2212 by 1659 pixels. Fundus photo:
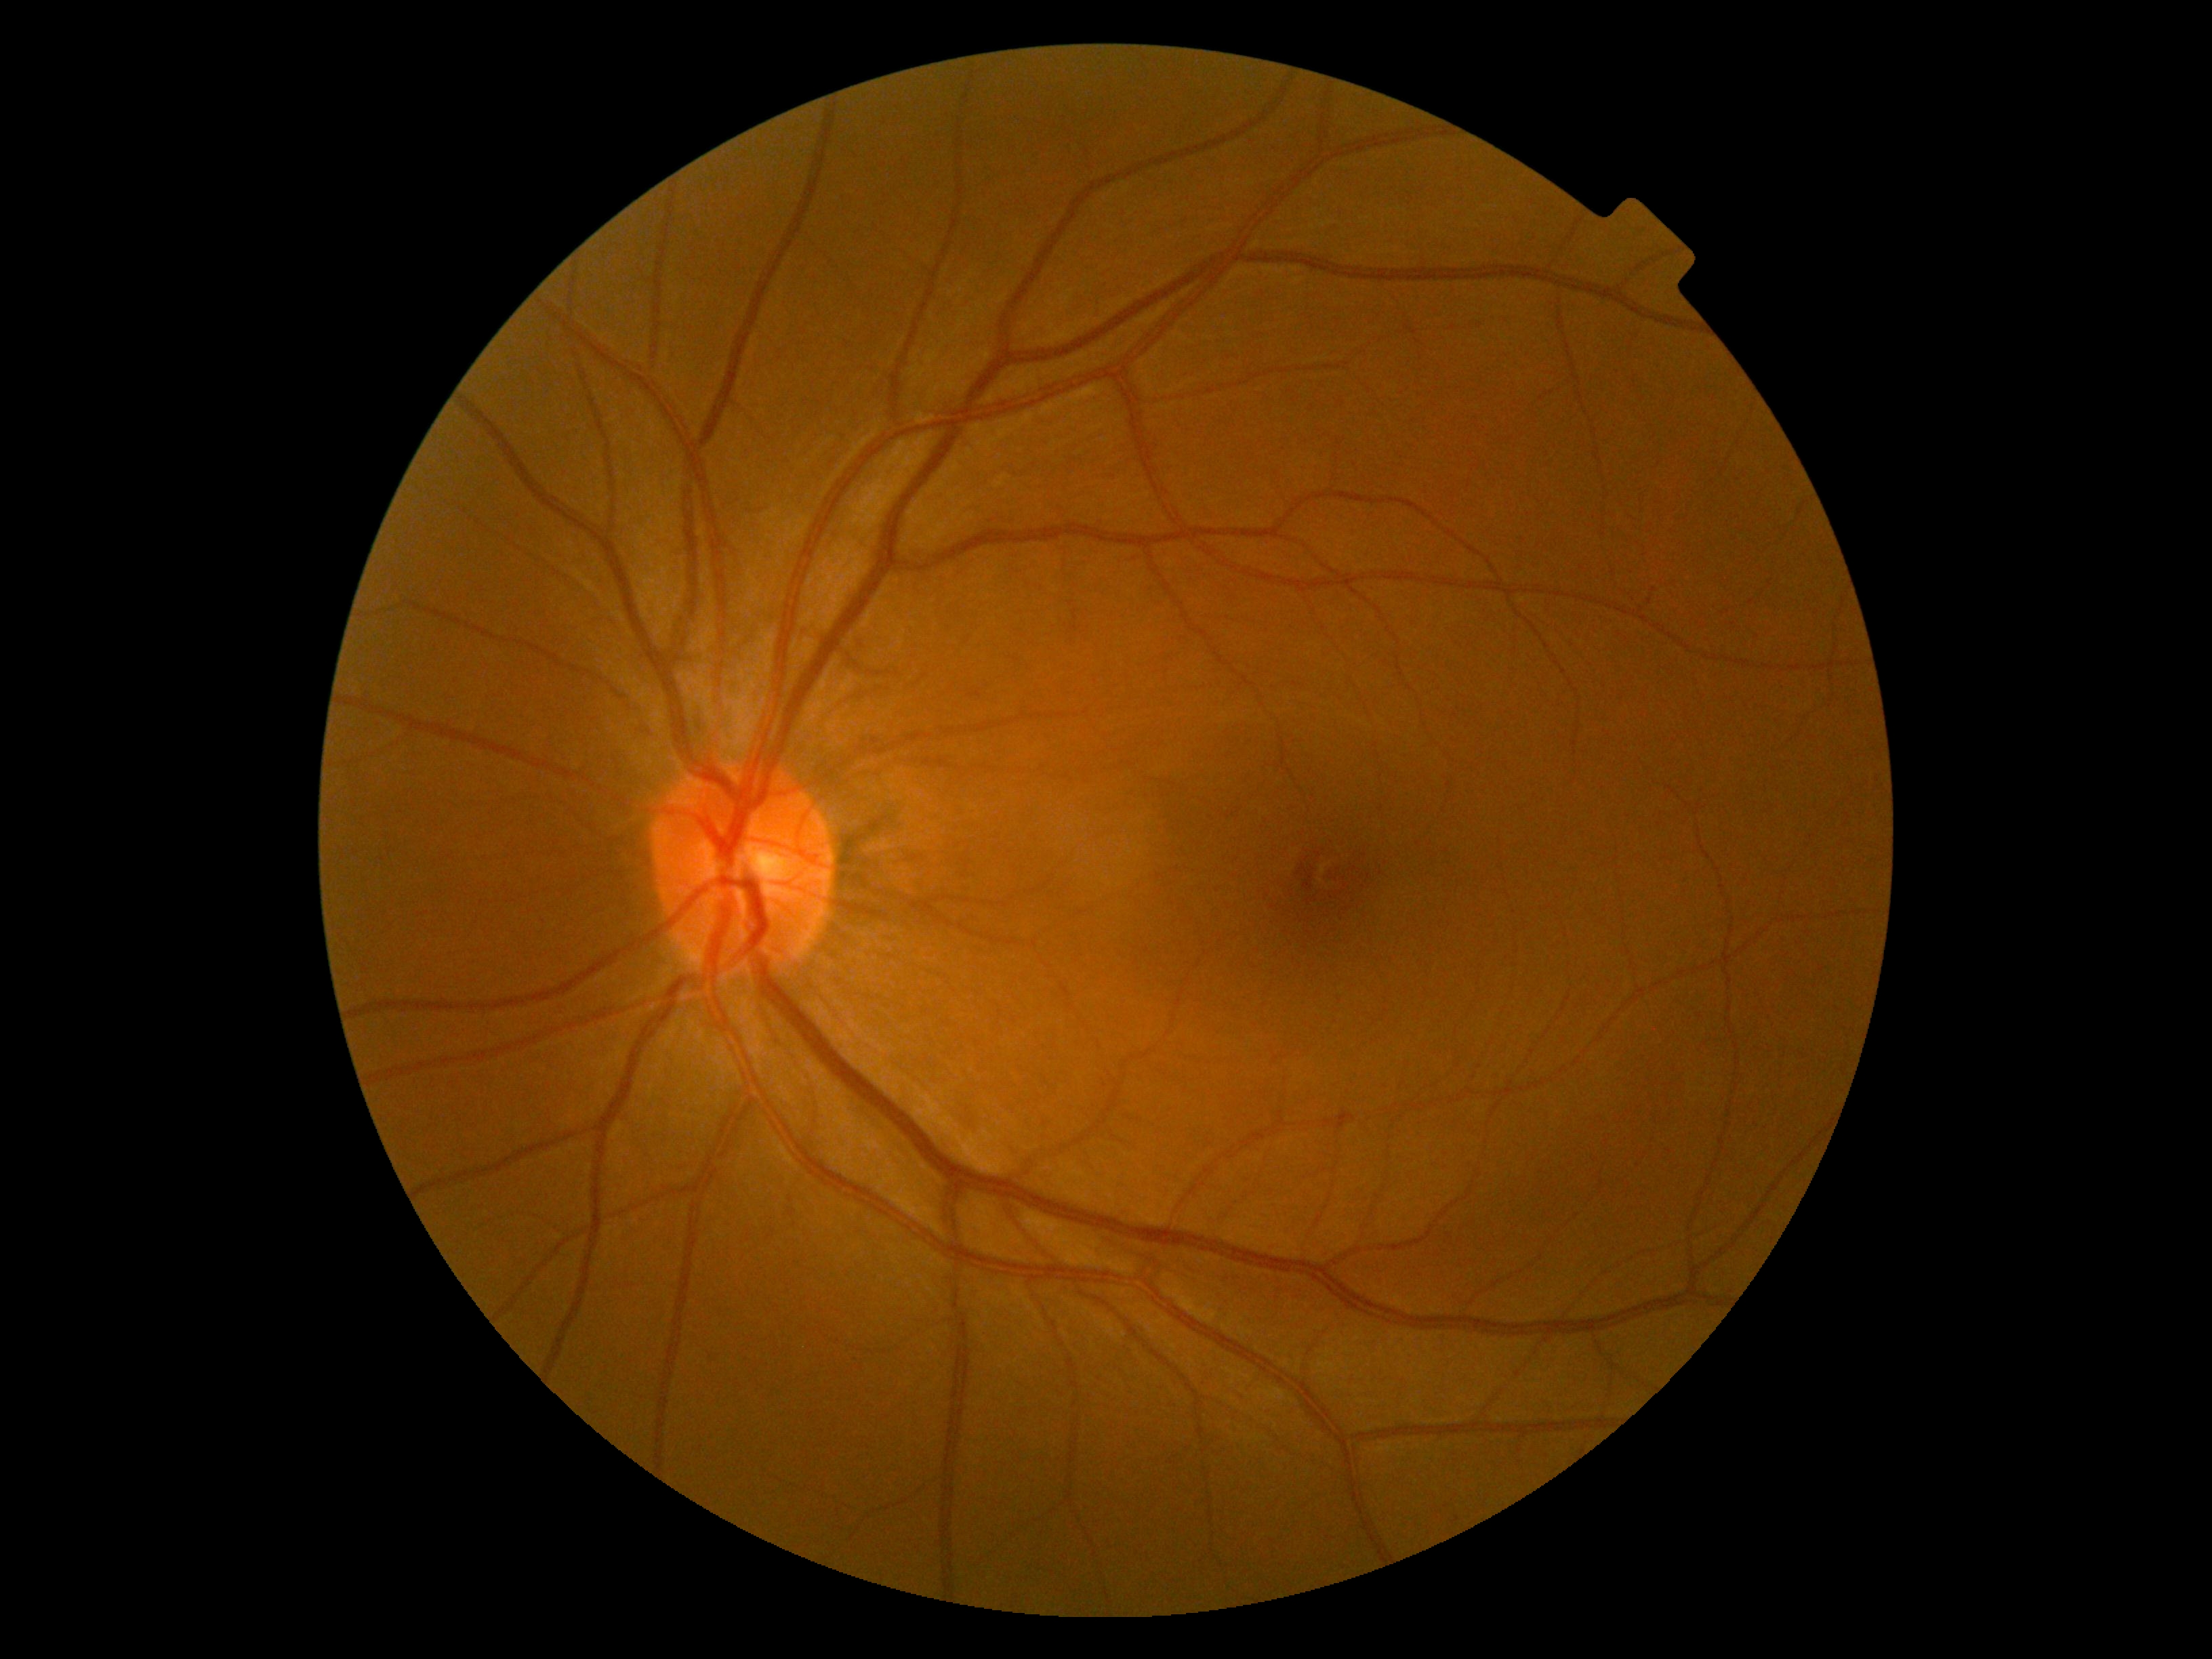 diabetic retinopathy grade: no apparent retinopathy (0)